45° field of view: 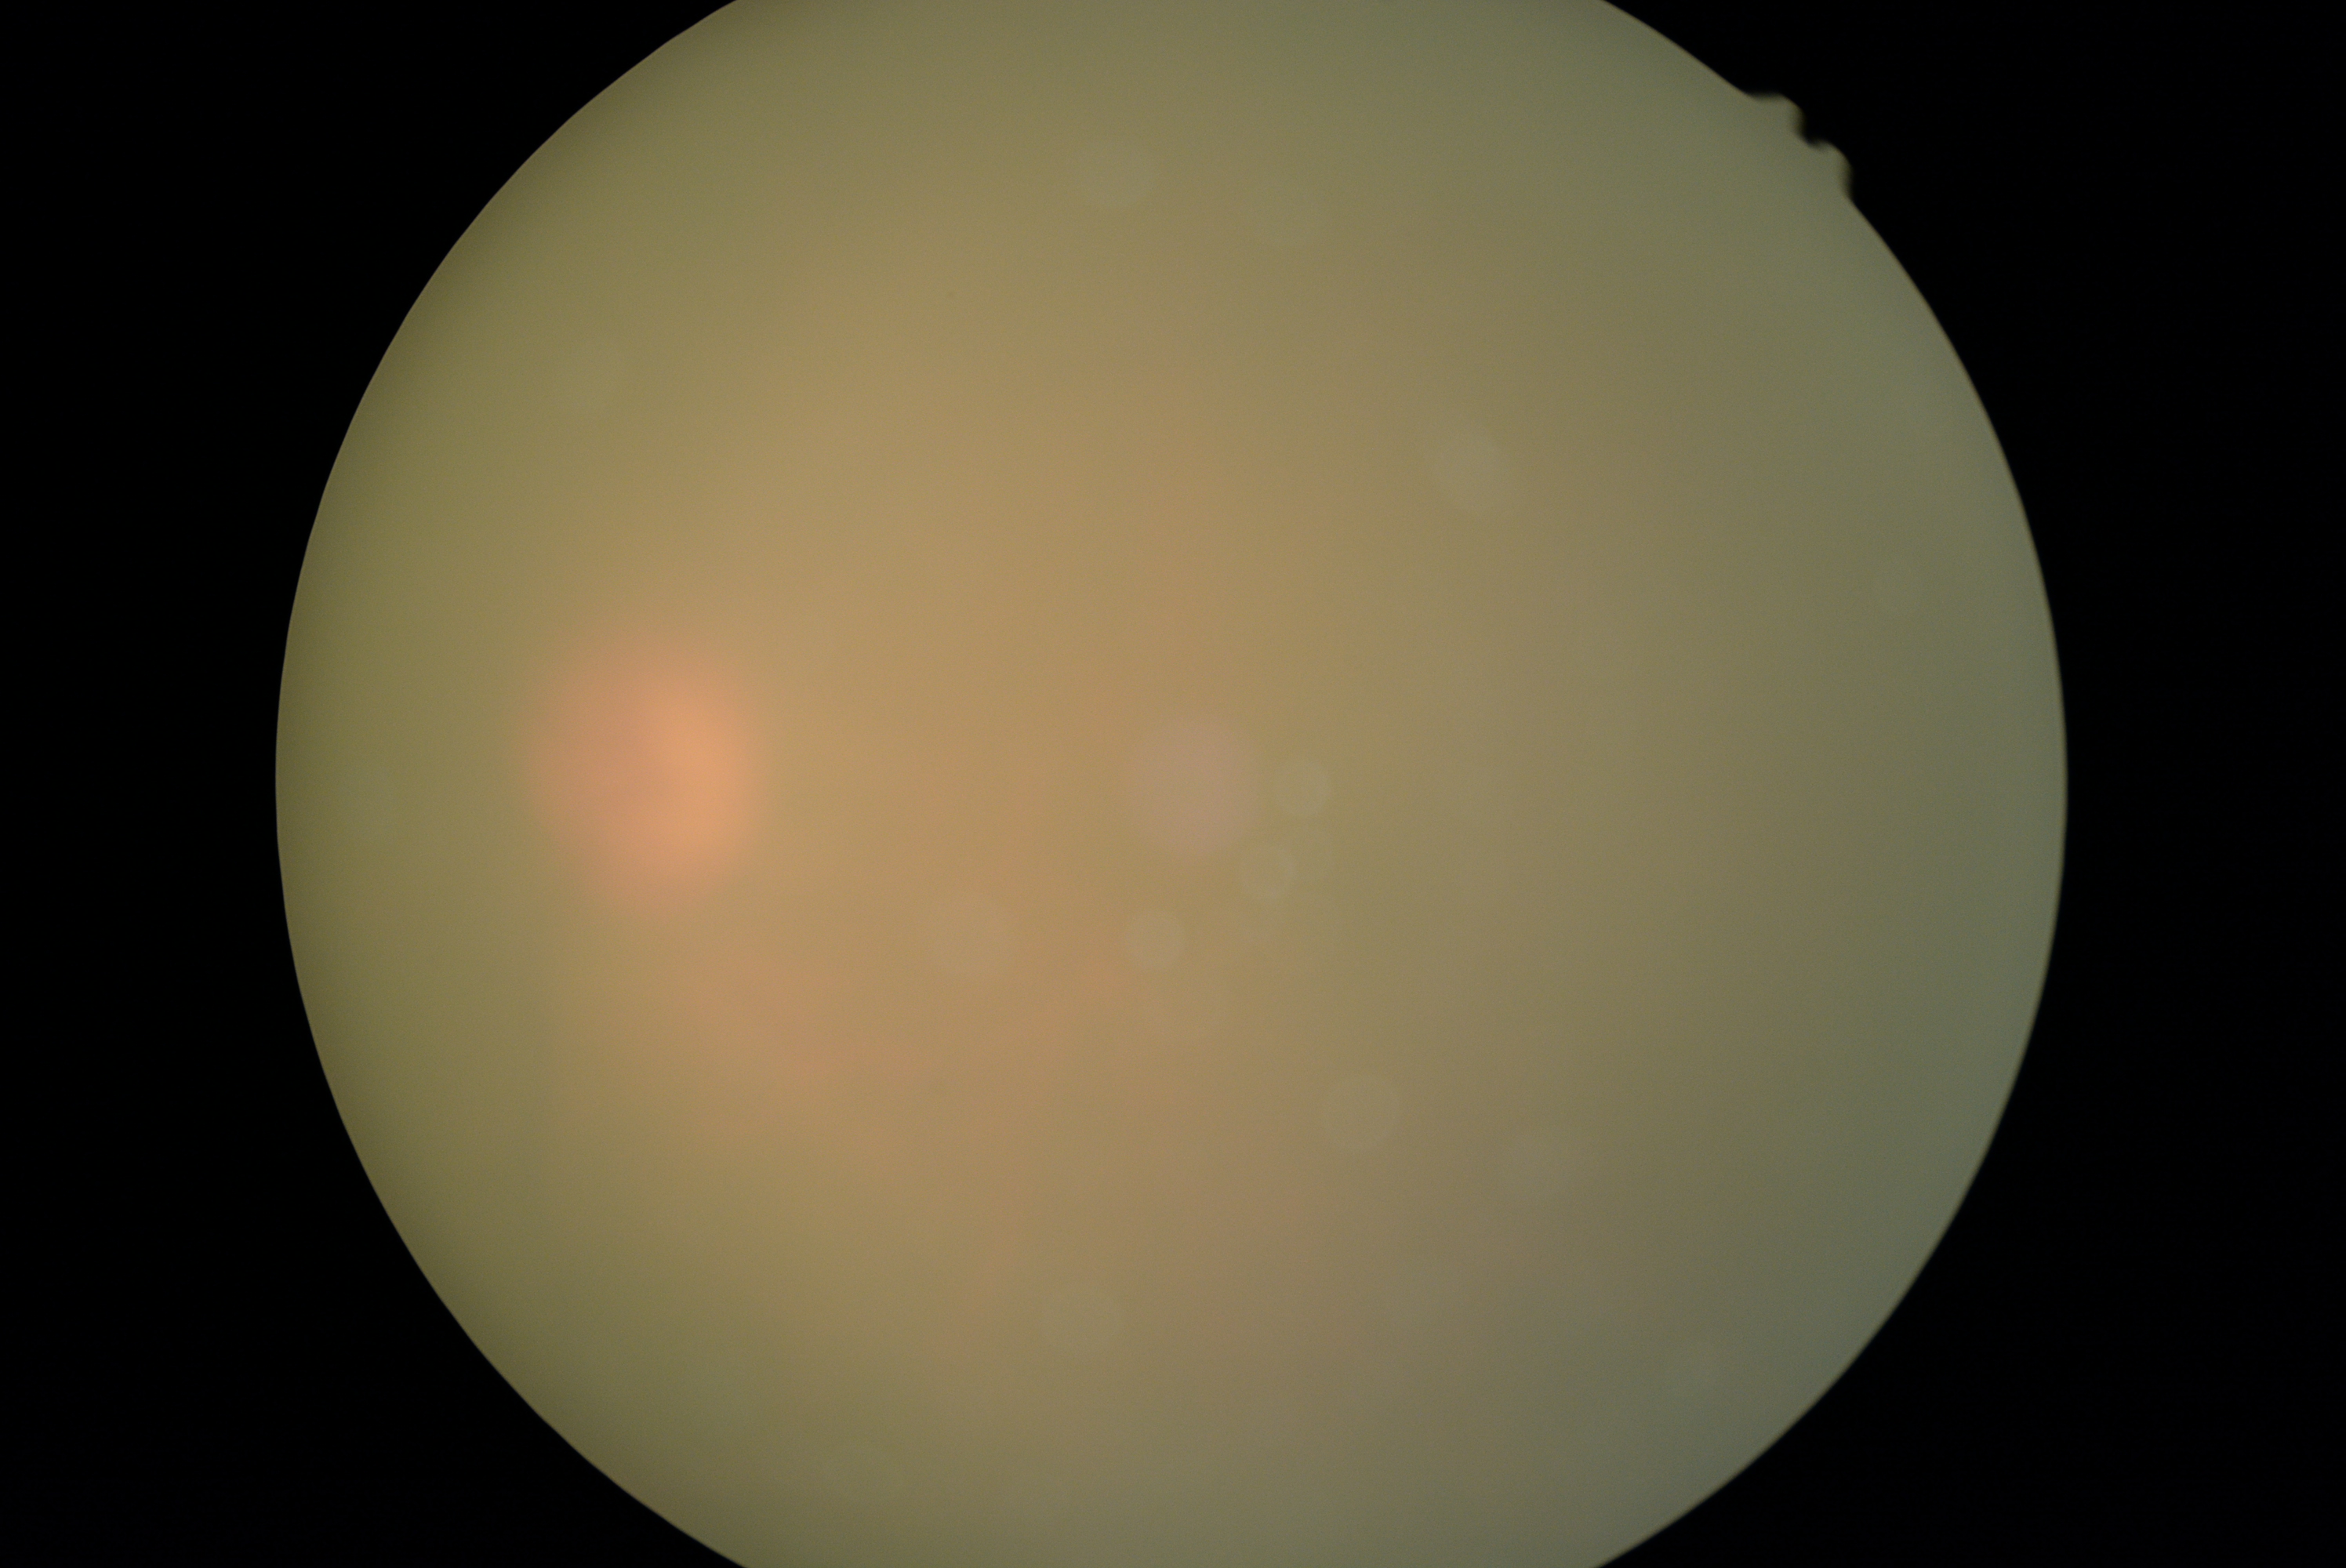

Quality too poor to assess for DR.
DR stage is ungradable due to poor image quality.